45 degree fundus photograph · acquired with a NIDEK AFC-230 — 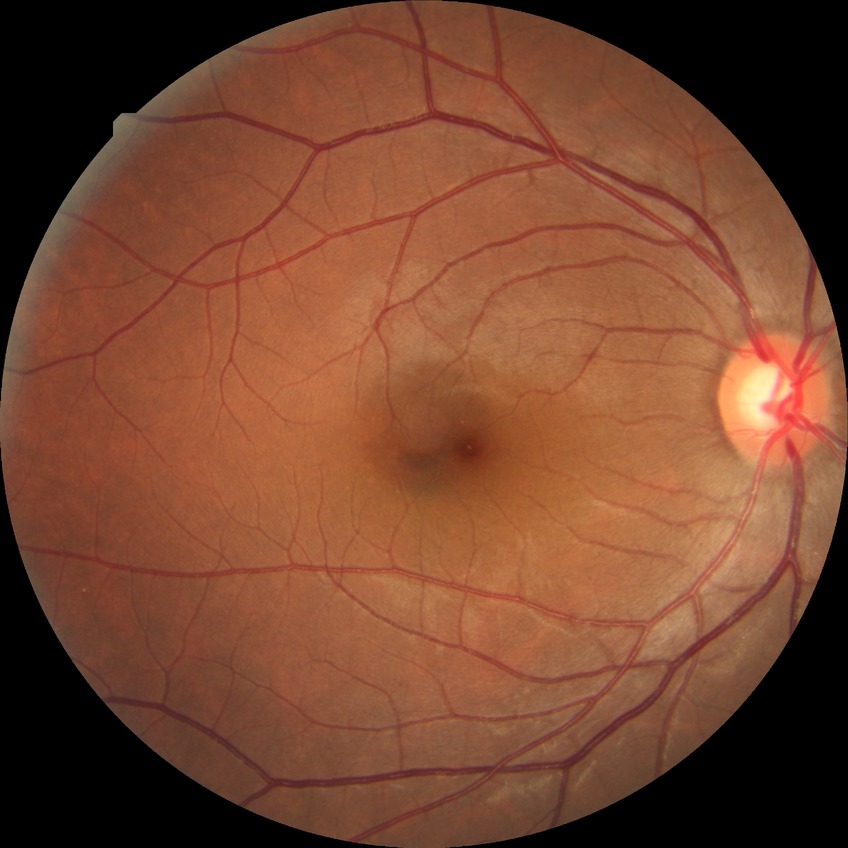 - retinopathy stage: no diabetic retinopathy